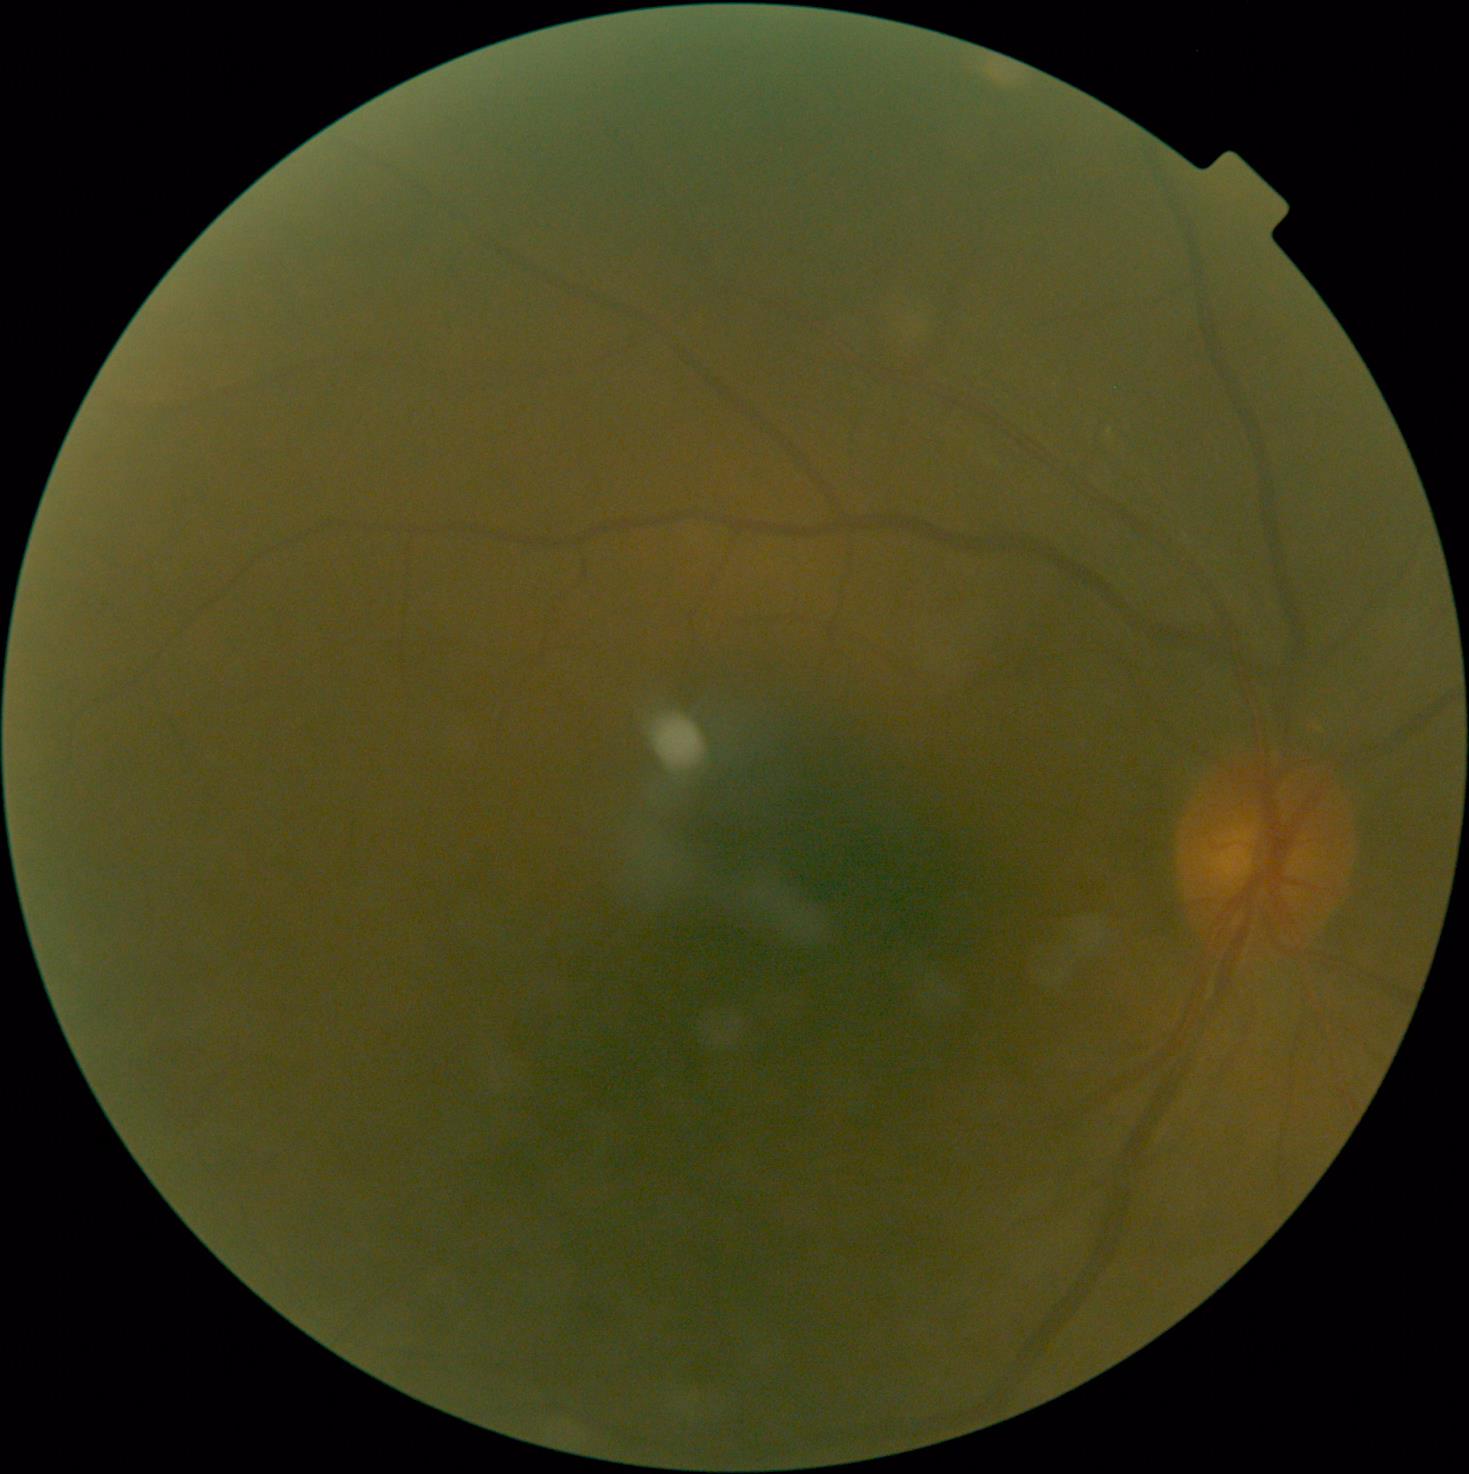
DR severity is 0.
No DR findings.